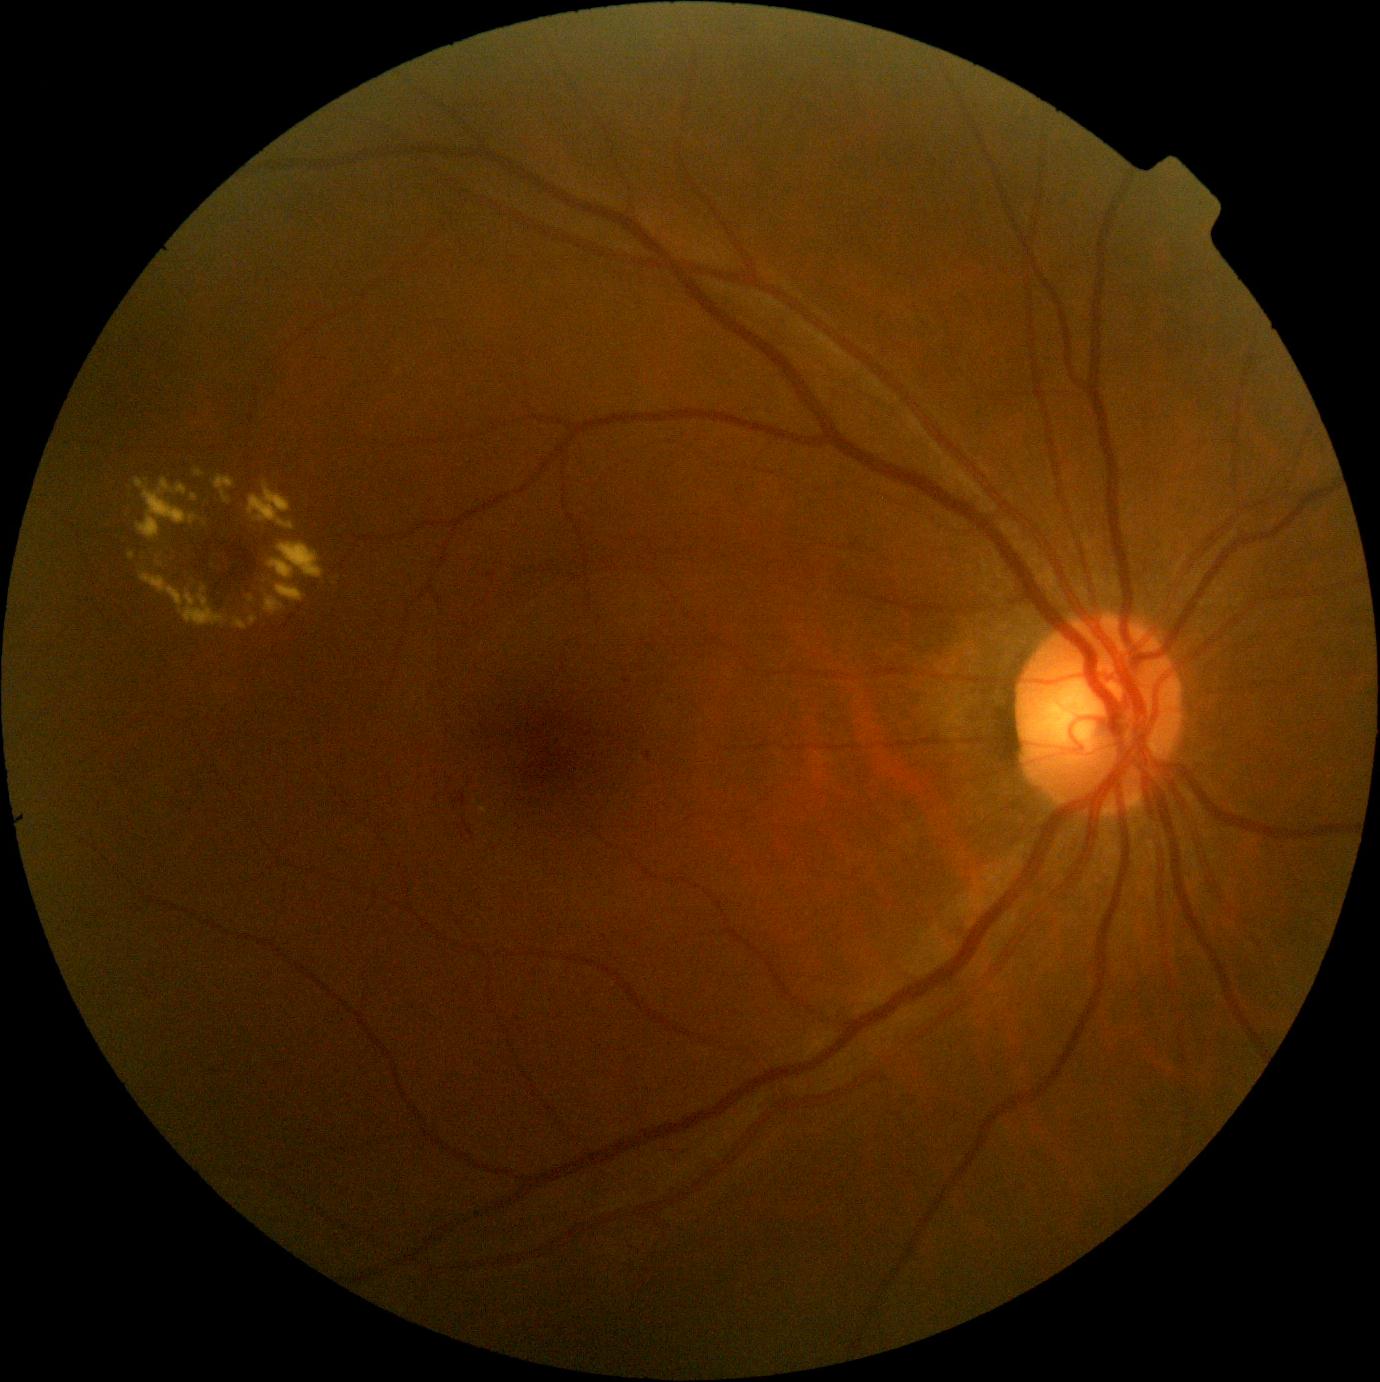
Retinopathy is grade 2 (moderate NPDR).
DR class: non-proliferative diabetic retinopathy.